Wide-field fundus photograph of an infant:
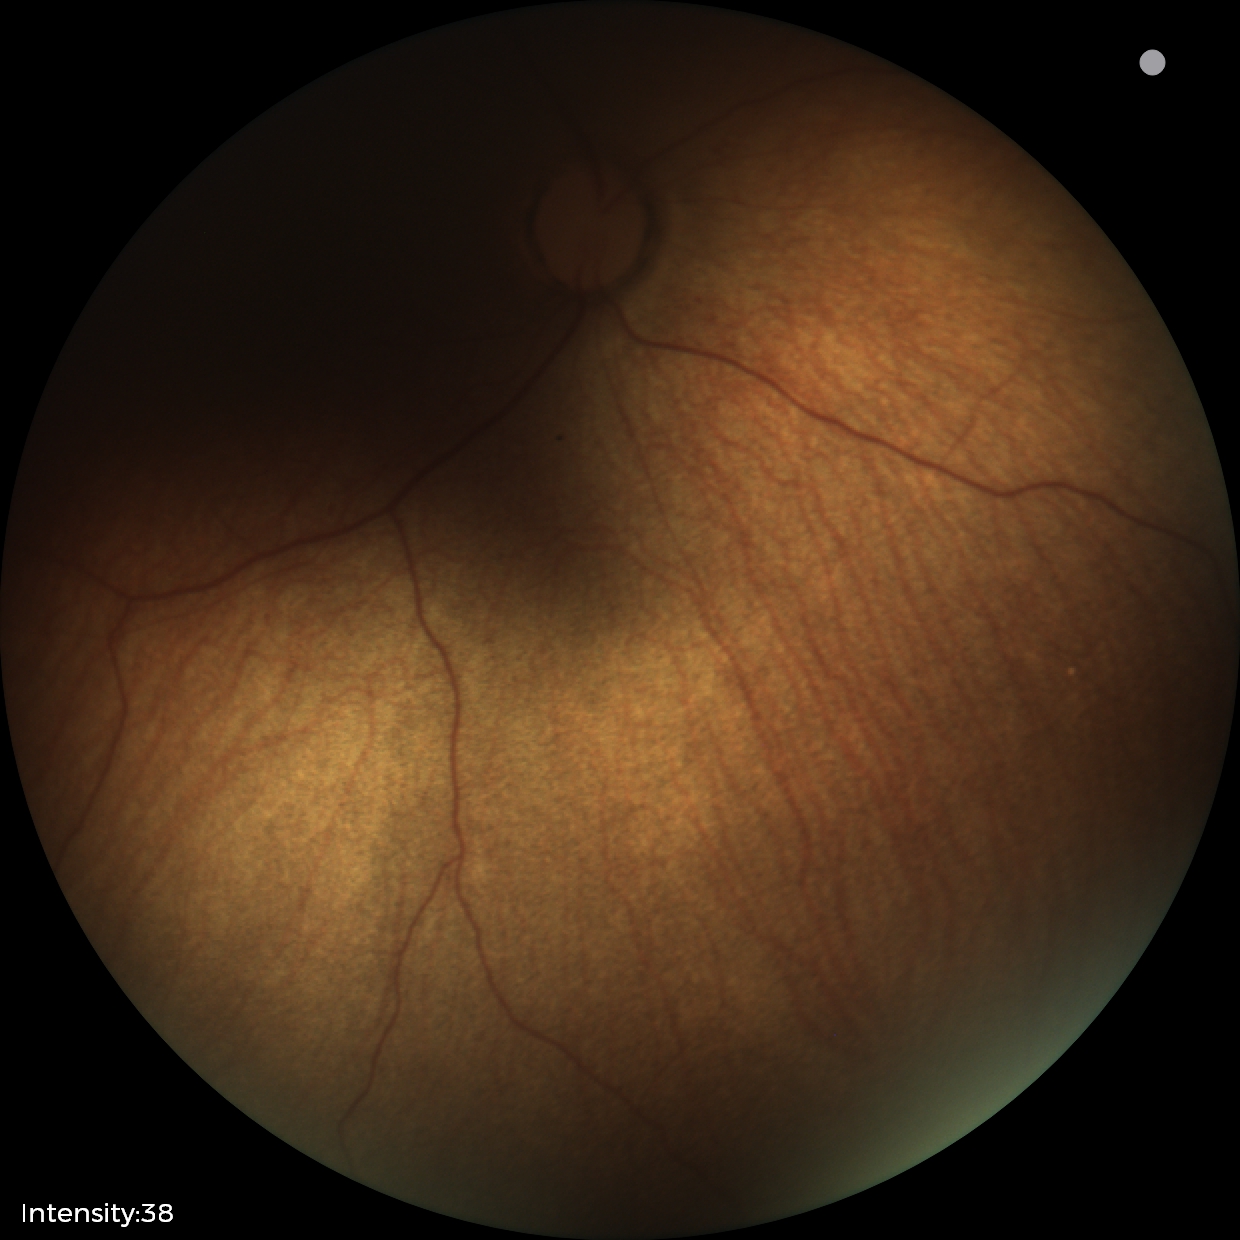
Q: What was the screening finding?
A: physiological appearance with no retinal pathology